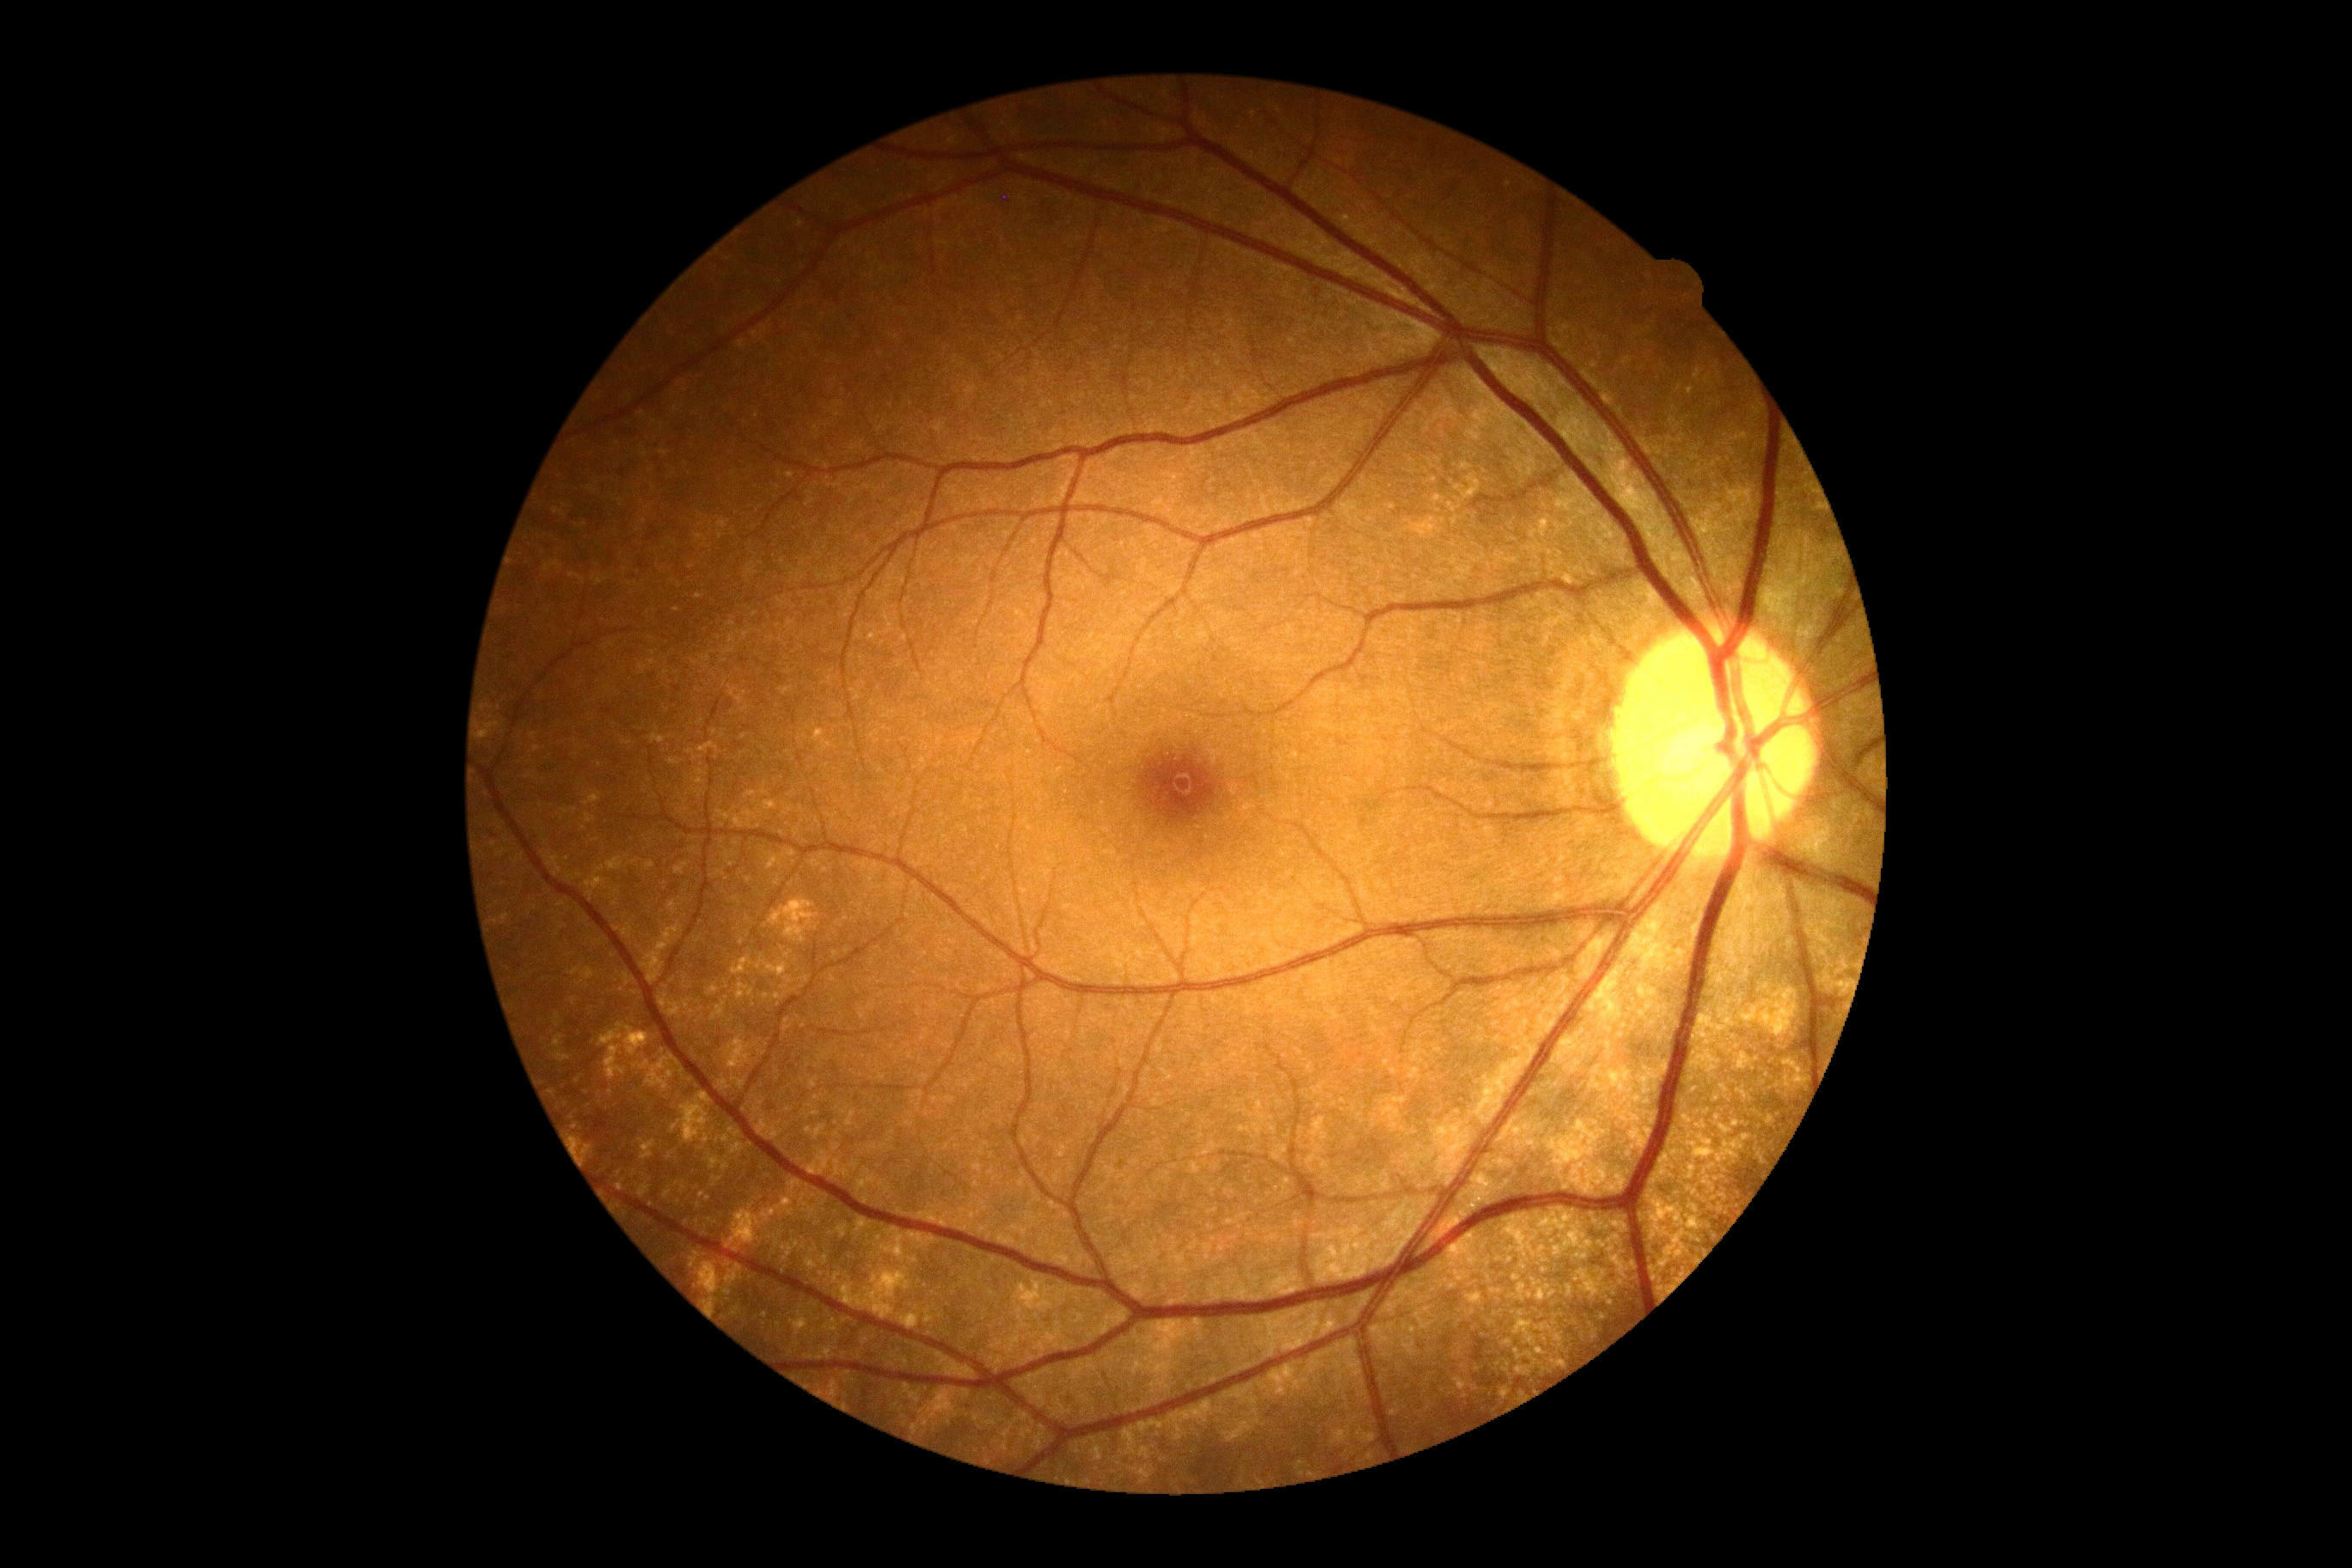

{
  "dr_impression": "negative for DR",
  "dr_grade": "no apparent diabetic retinopathy (grade 0)"
}